Nonmydriatic fundus photograph.
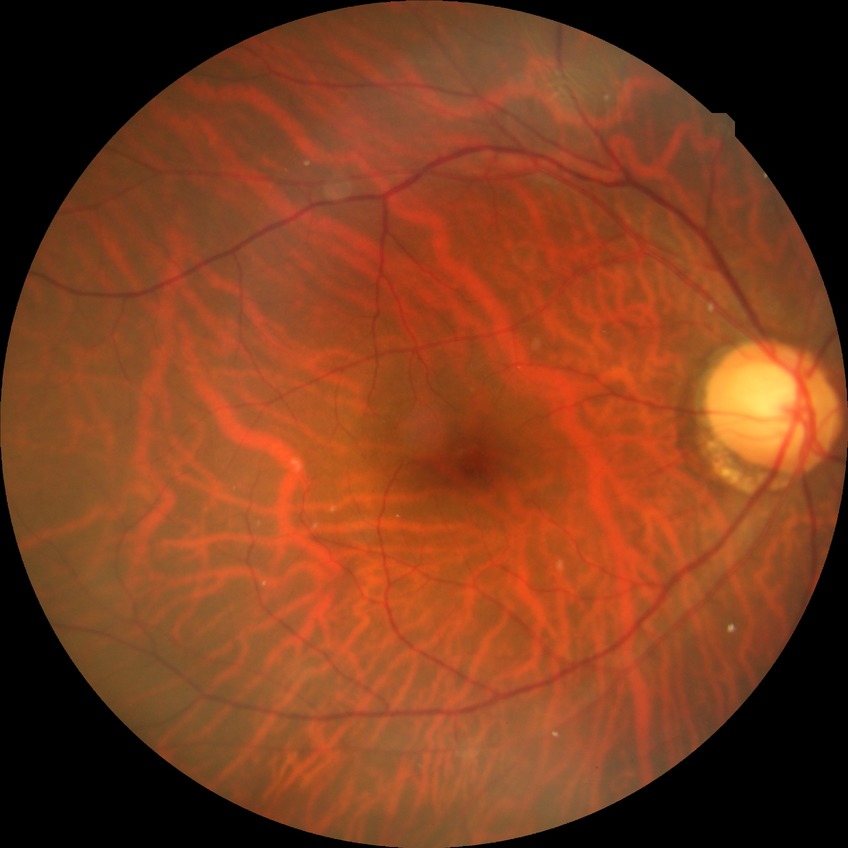
diabetic retinopathy (DR): NDR (no diabetic retinopathy).